Camera: NIDEK AFC-230.
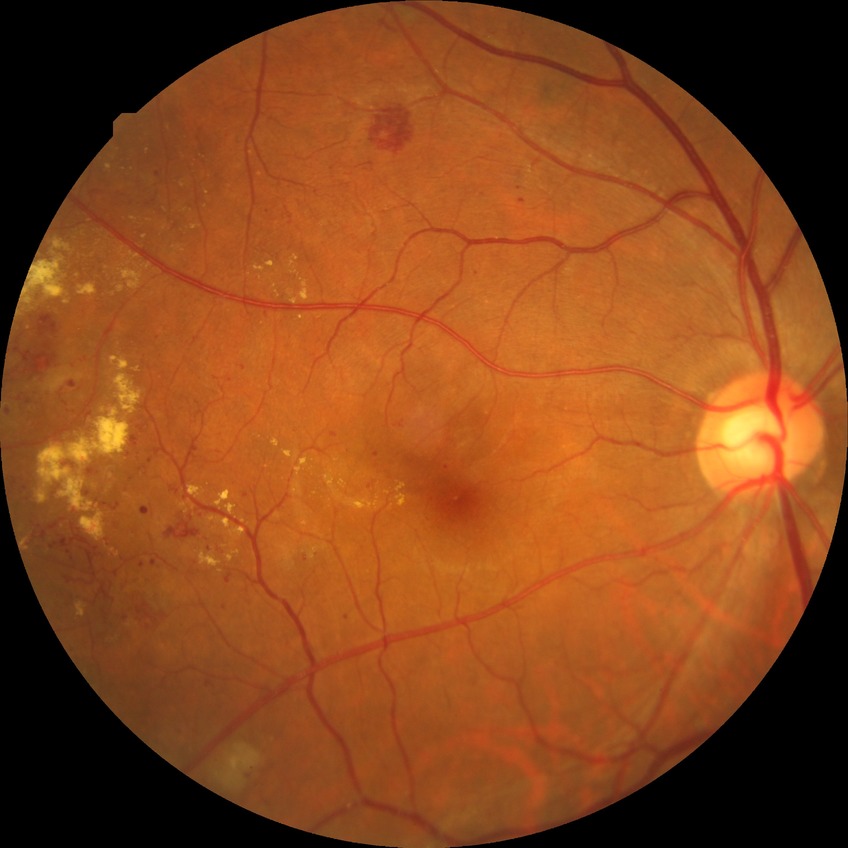
Davis grading = proliferative diabetic retinopathy.